45° FOV
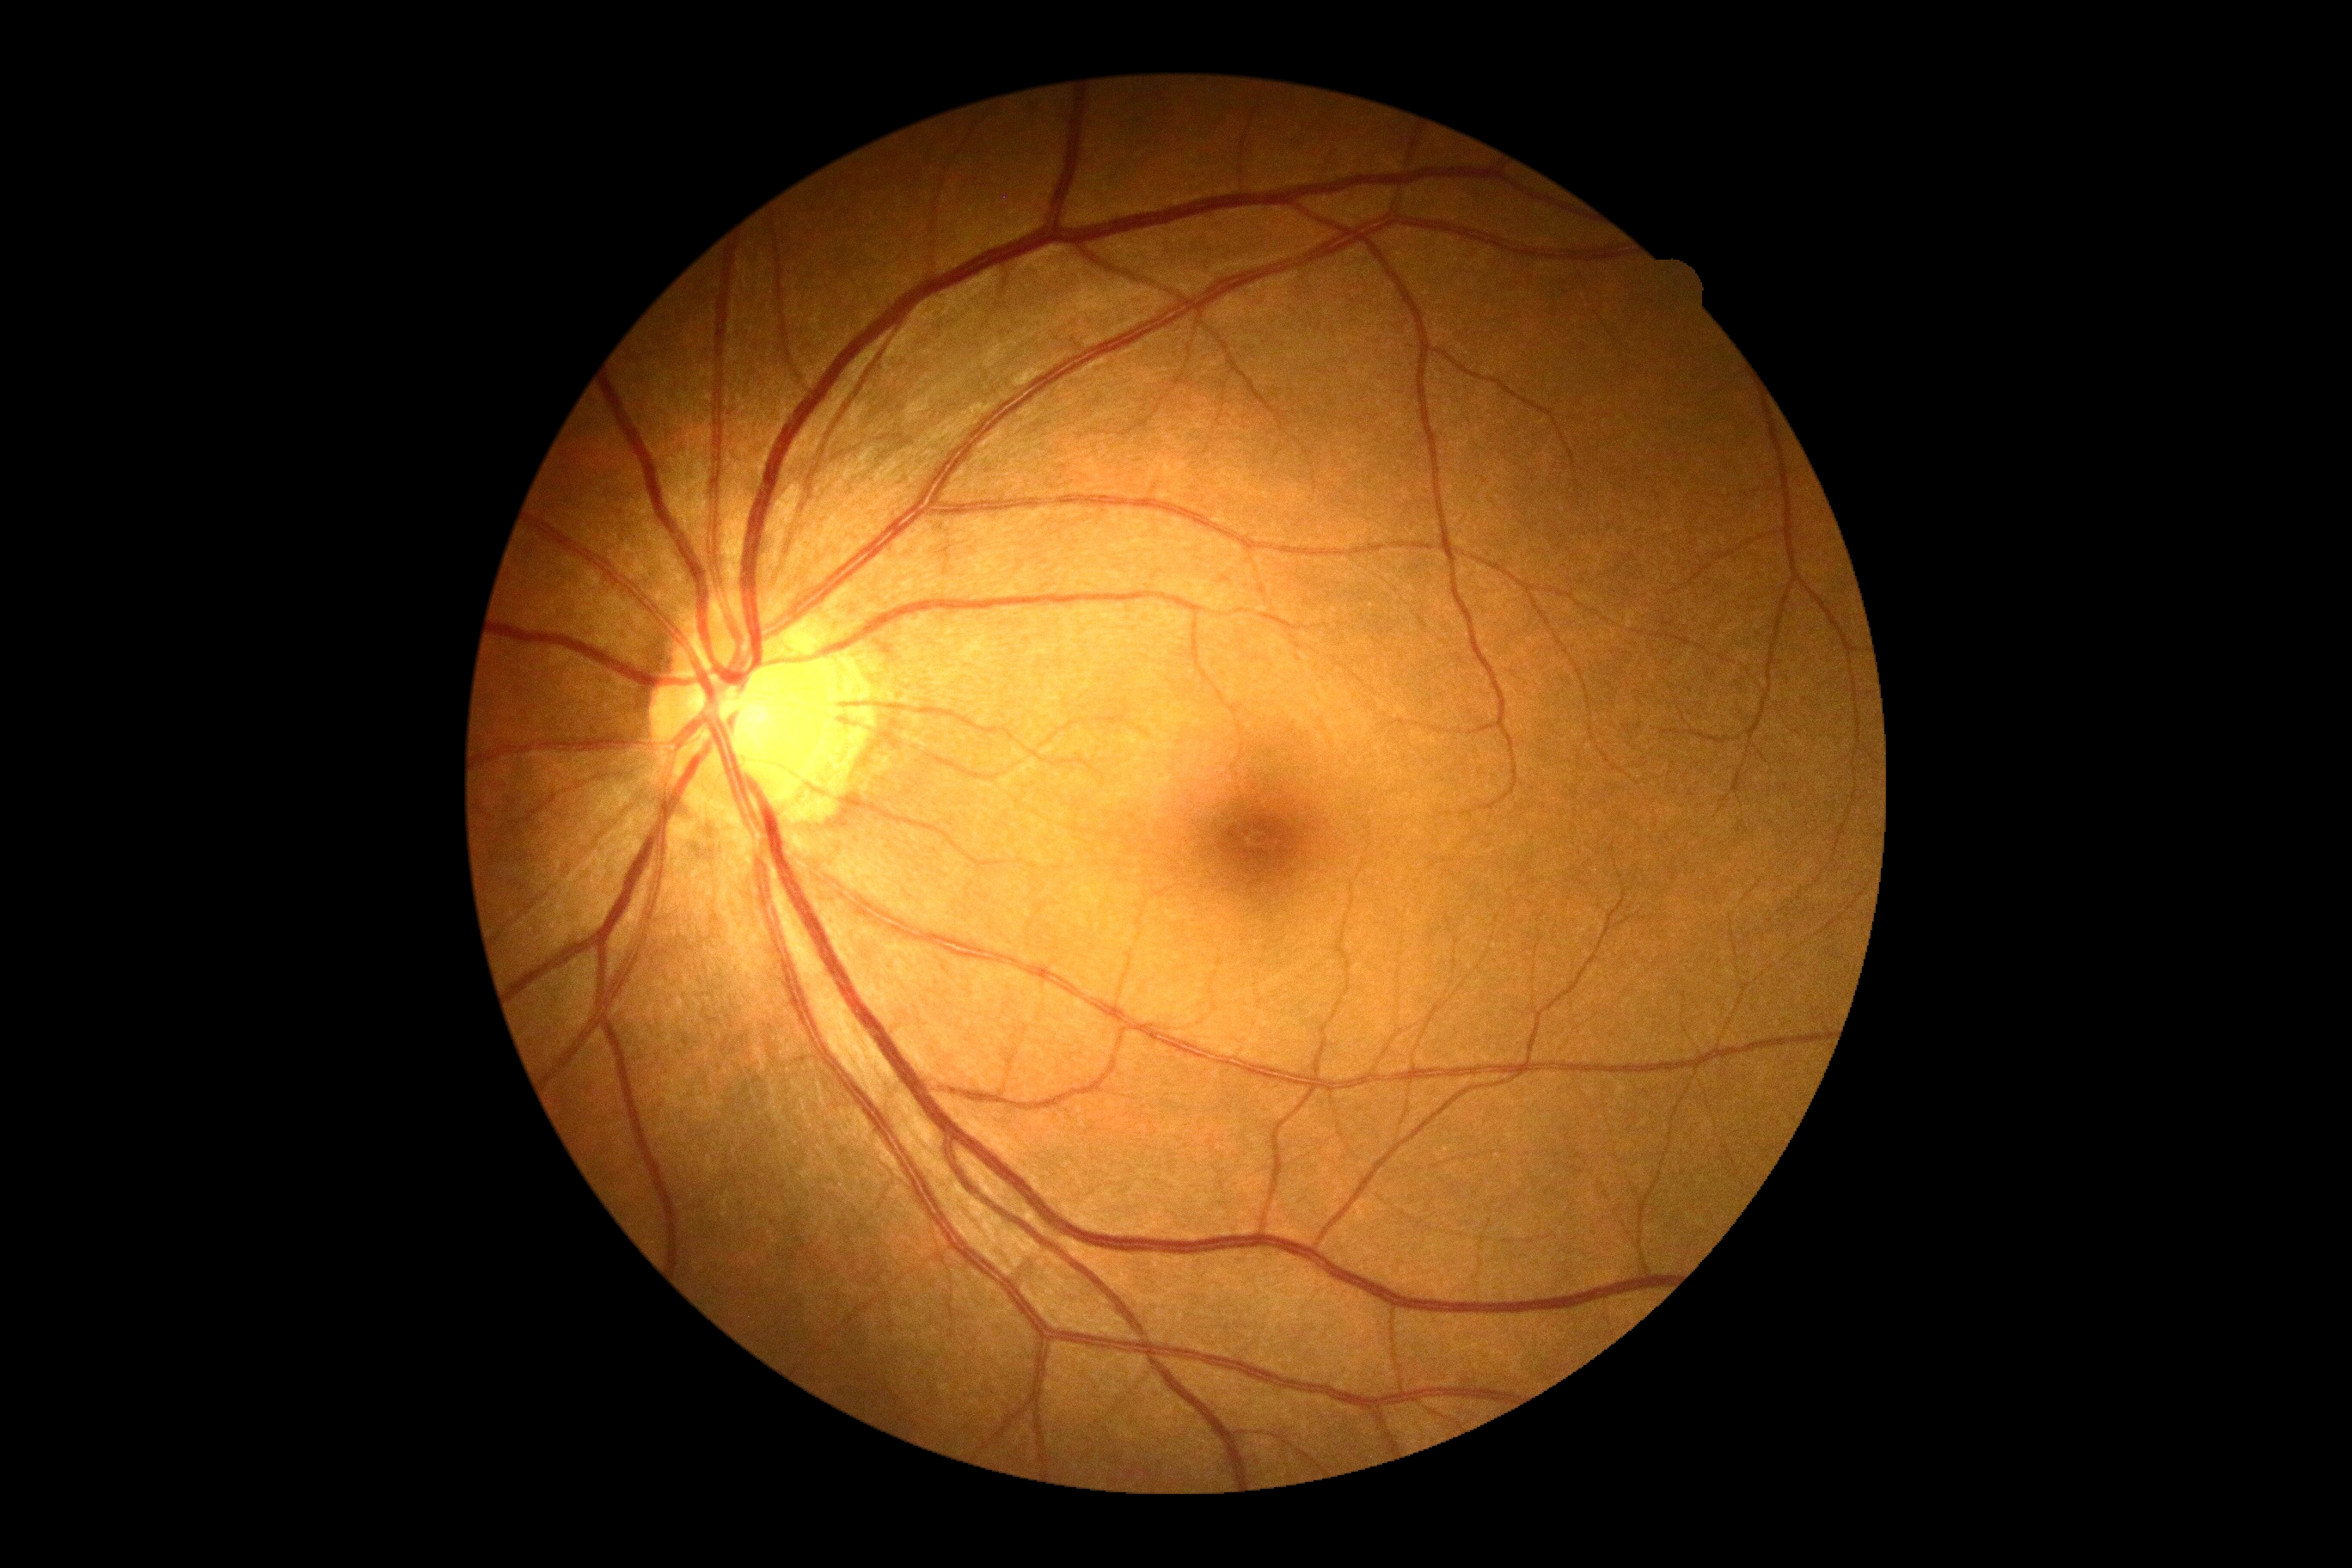
Annotations:
– DR severity: 0
– DR impression: negative for DR